848 x 848 pixels; color fundus image
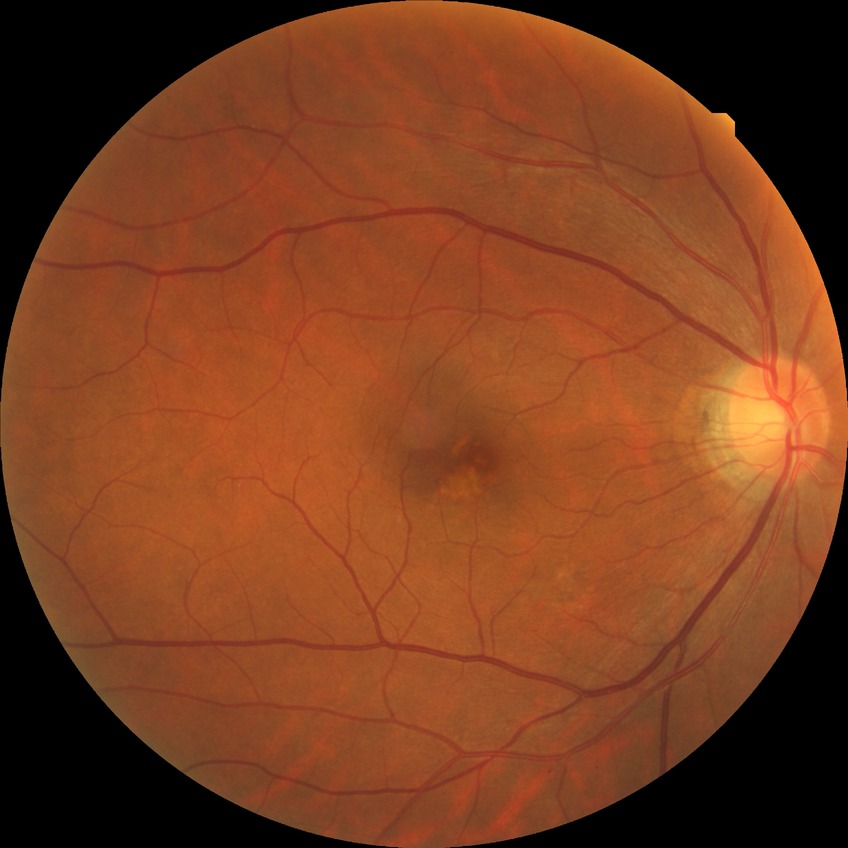
diabetic retinopathy severity: no diabetic retinopathy.